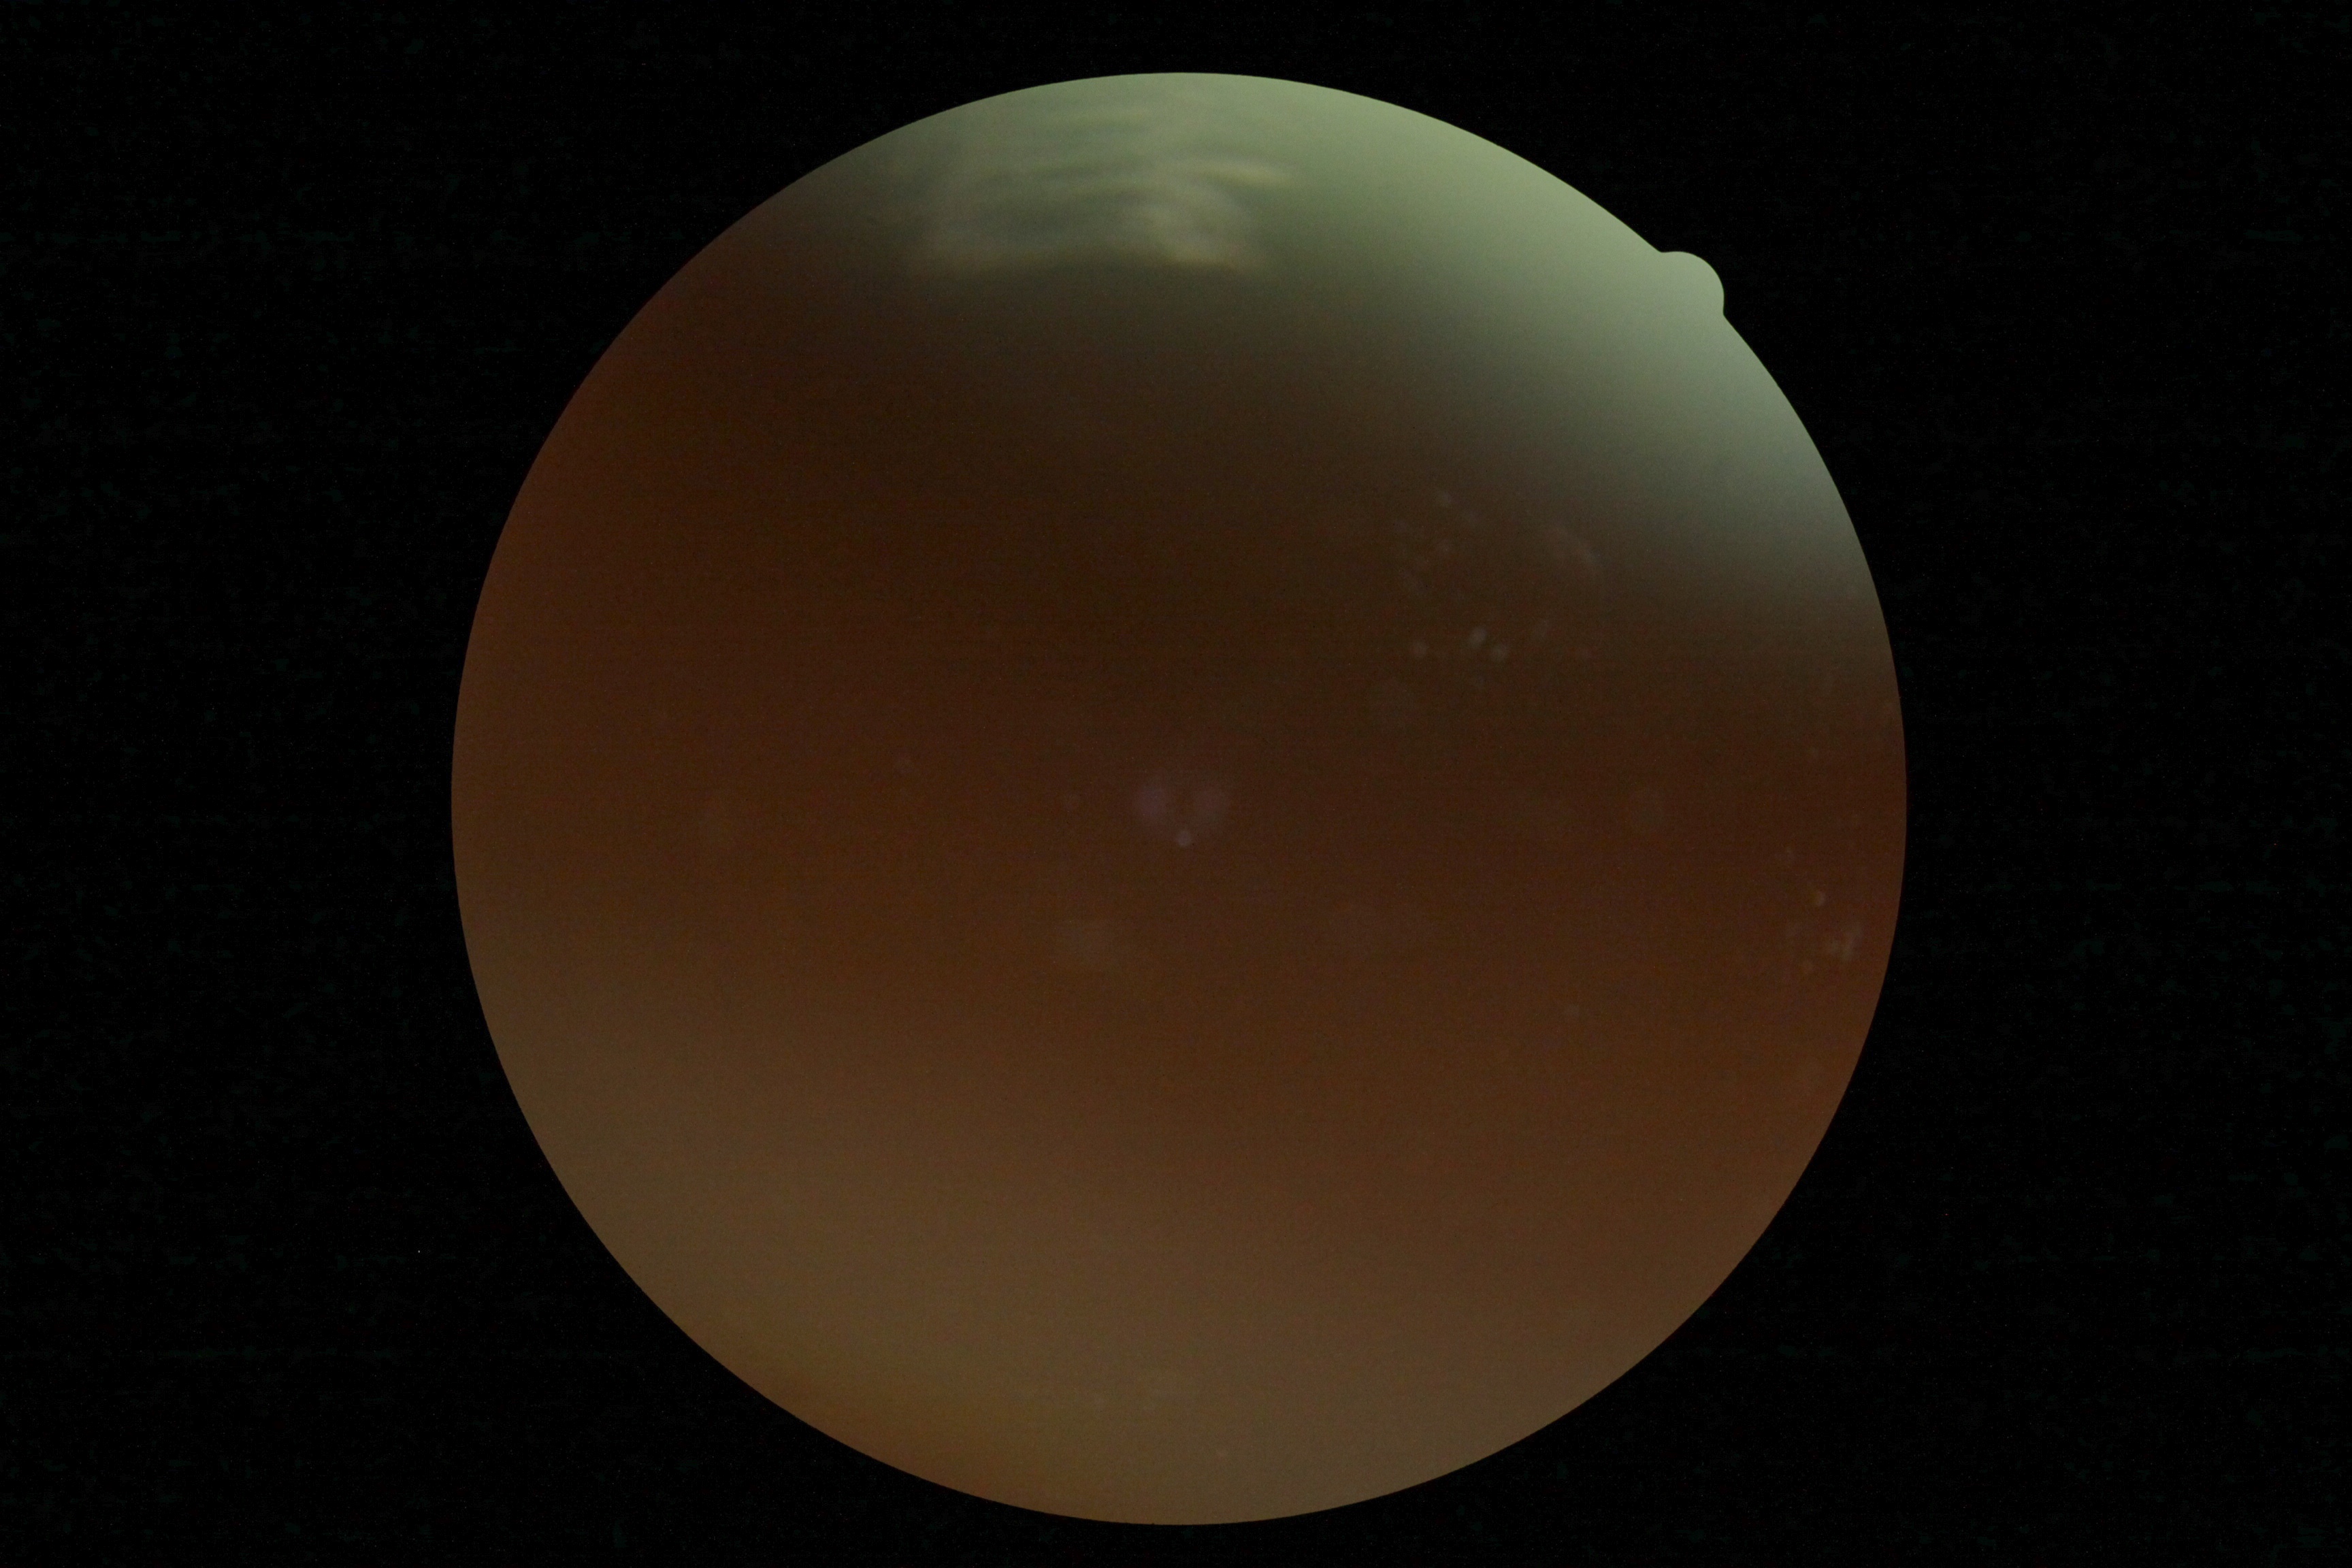
{"quality": "insufficient for DR assessment", "dr_grade": "ungradable due to poor image quality"}